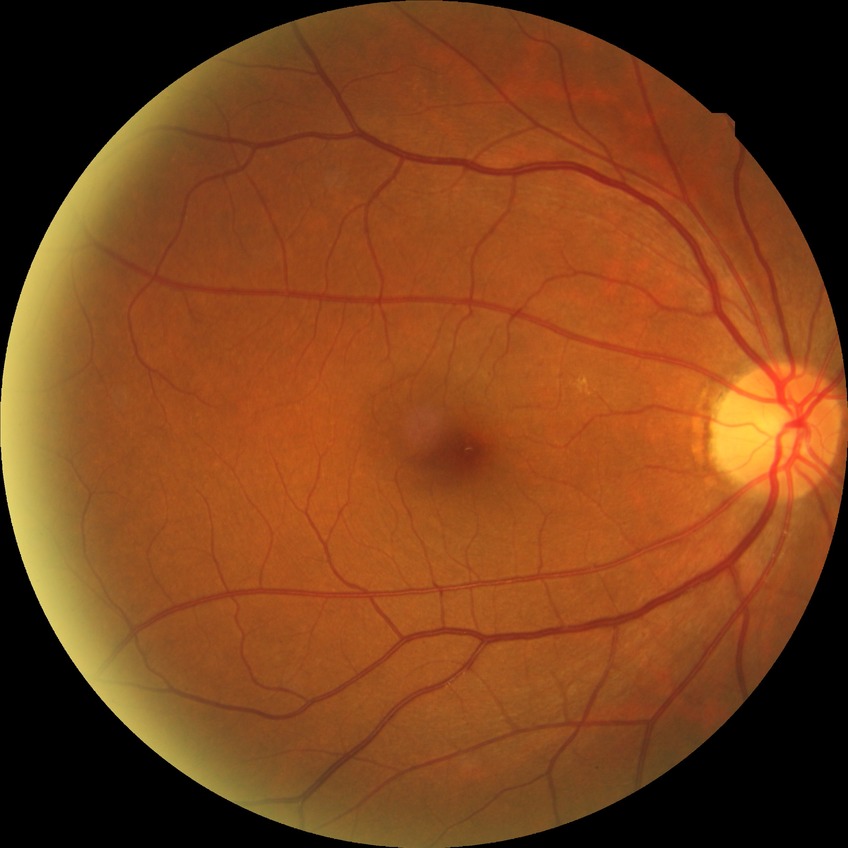 The retinopathy is classified as non-proliferative diabetic retinopathy. Retinopathy grade: simple diabetic retinopathy.